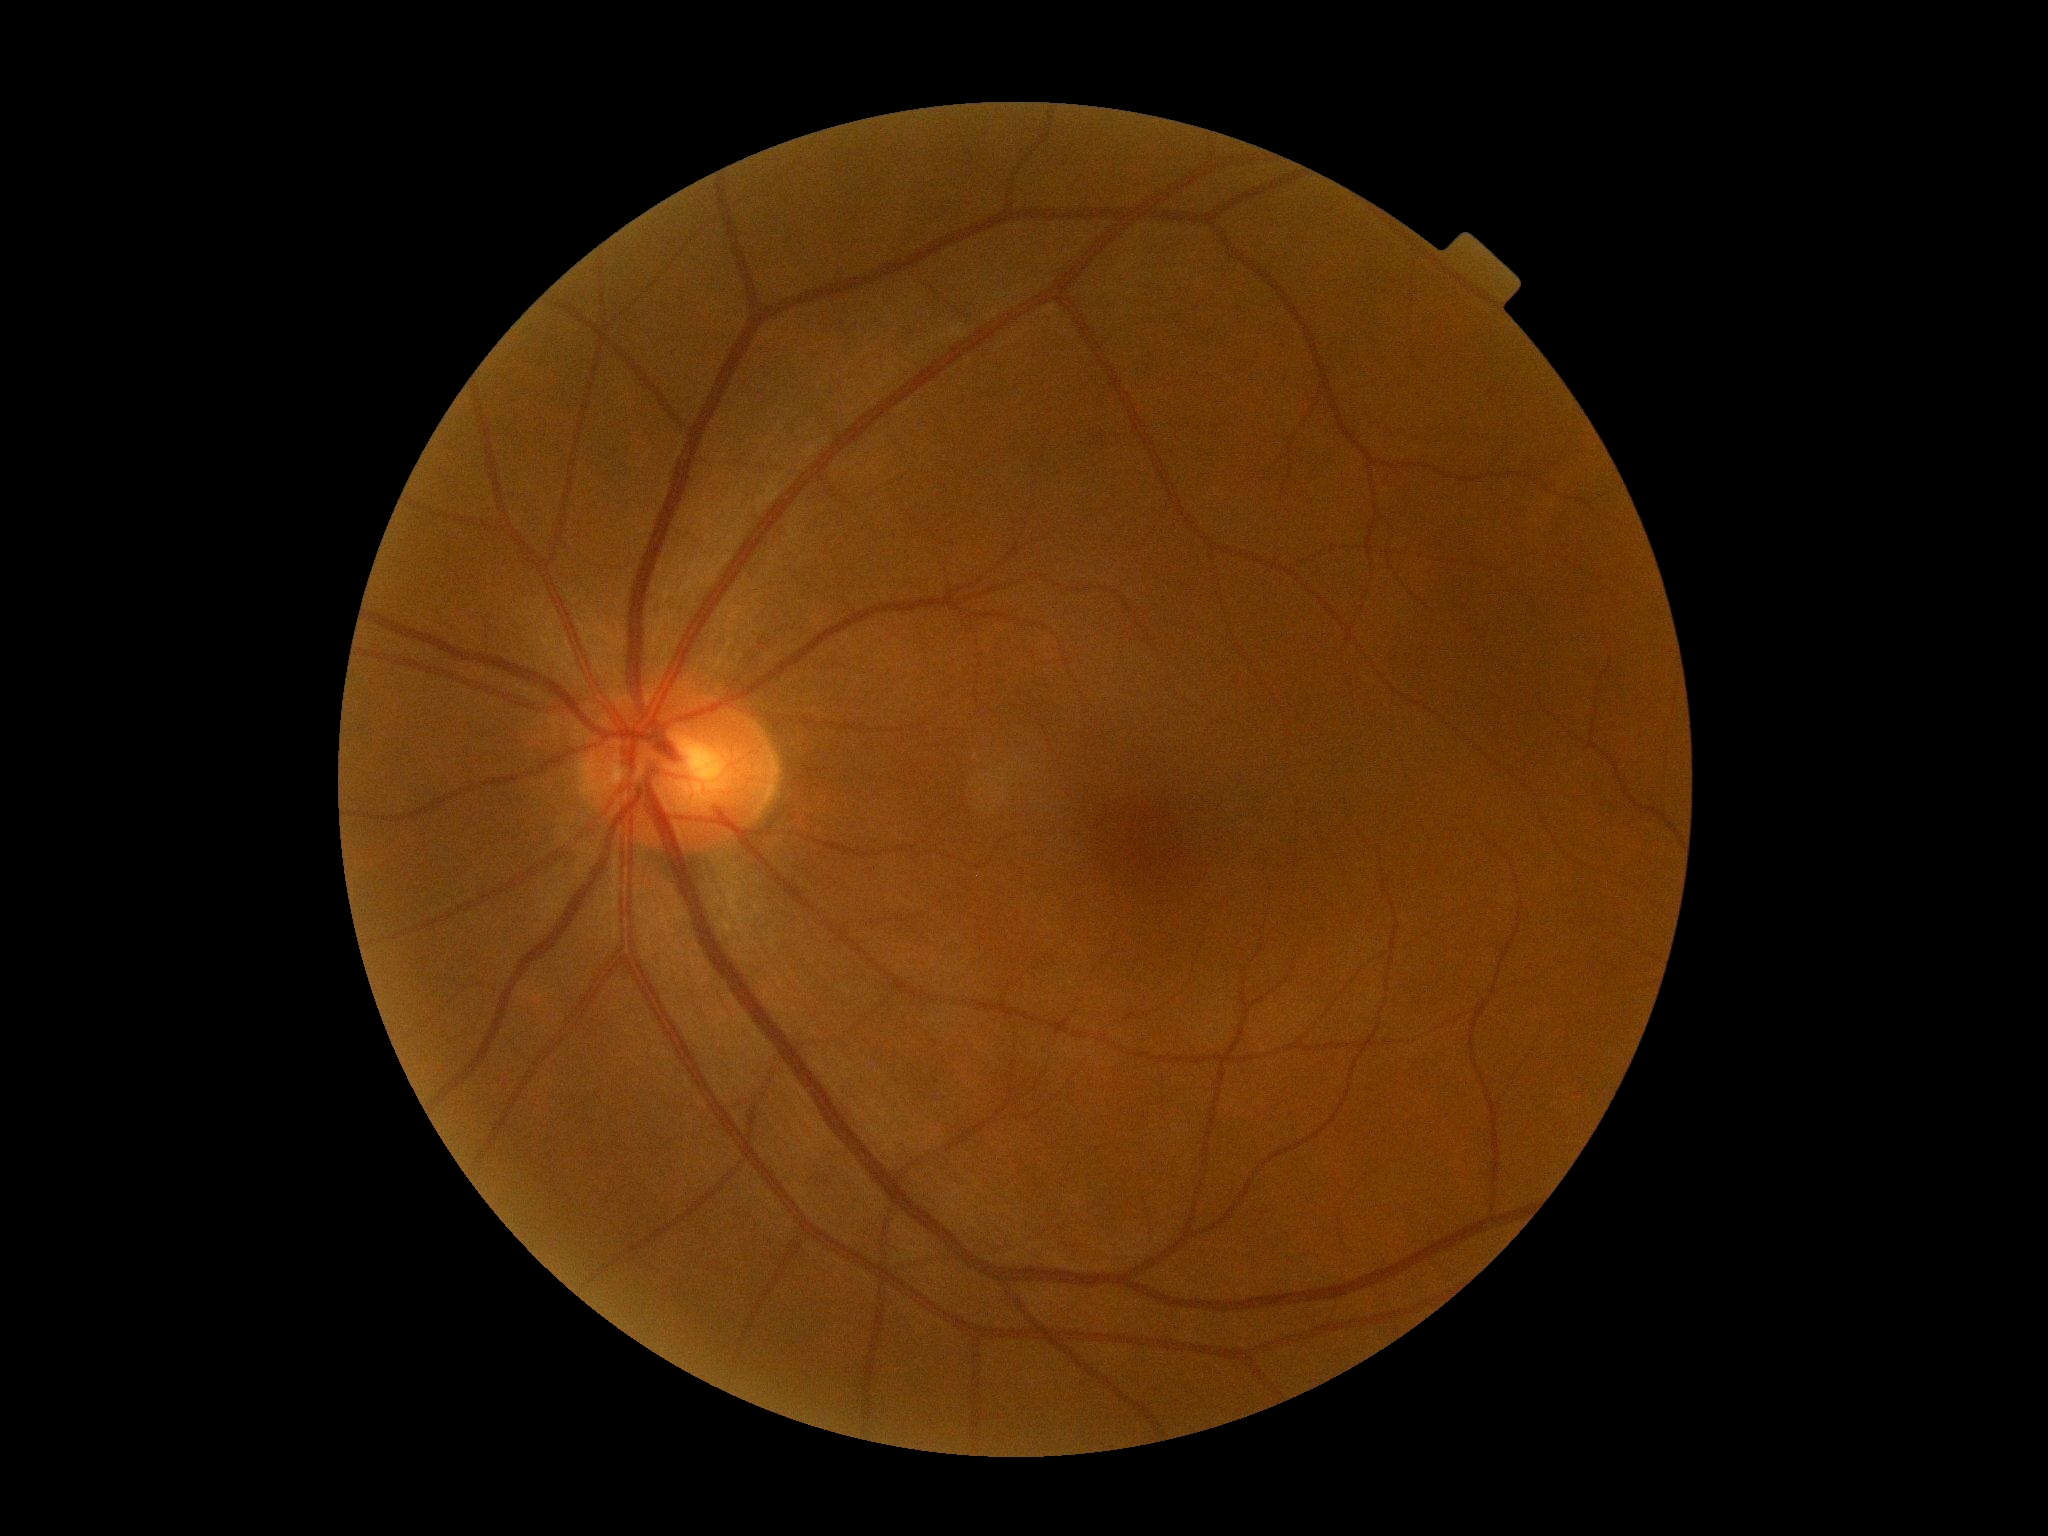

Diabetic retinopathy grade is no apparent diabetic retinopathy (0).